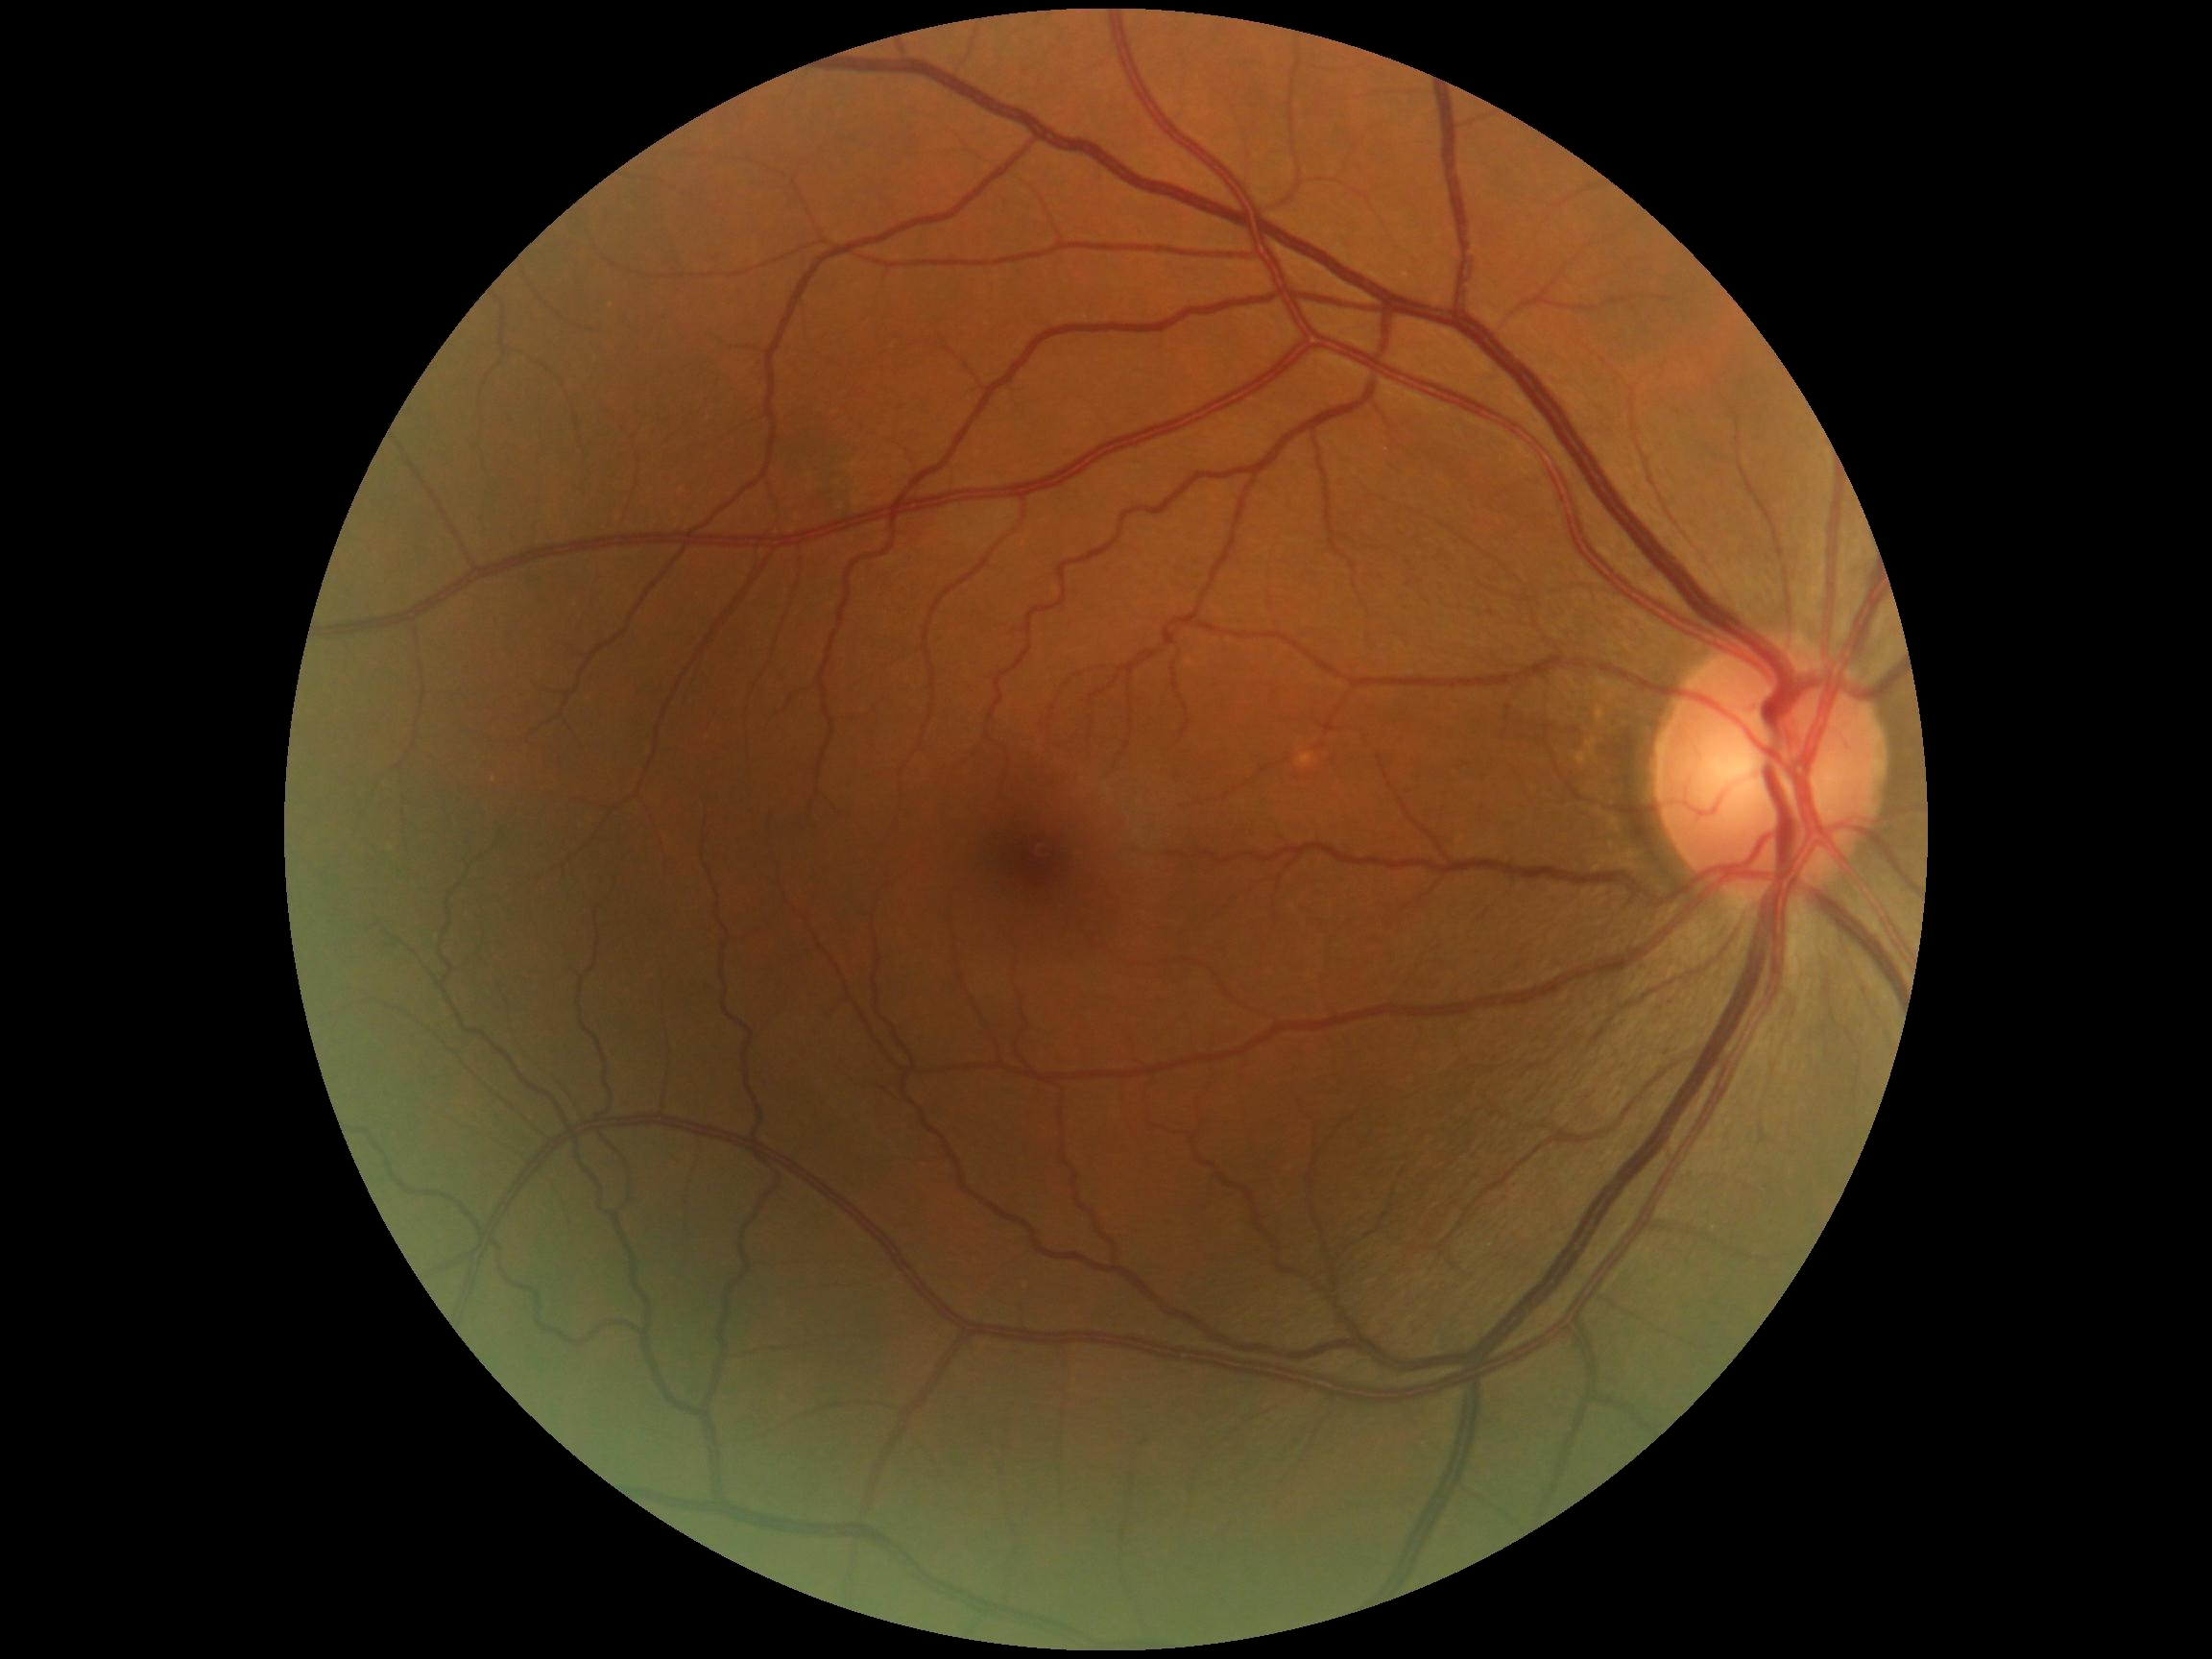

Diabetic retinopathy severity: no apparent retinopathy (grade 0).